Wide-field fundus photograph from neonatal ROP screening: 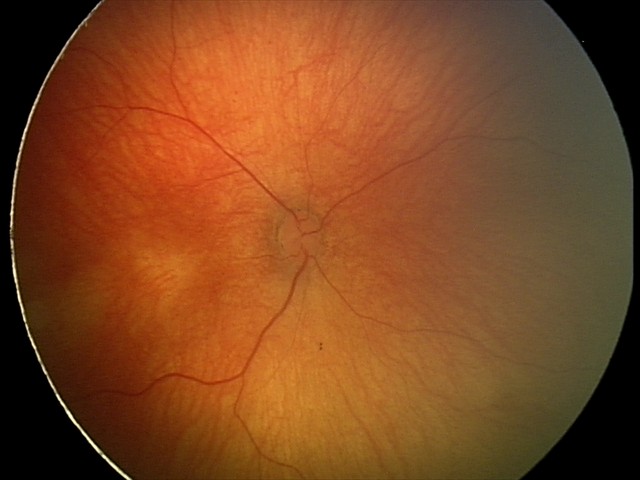

Normal screening examination.